CFP: 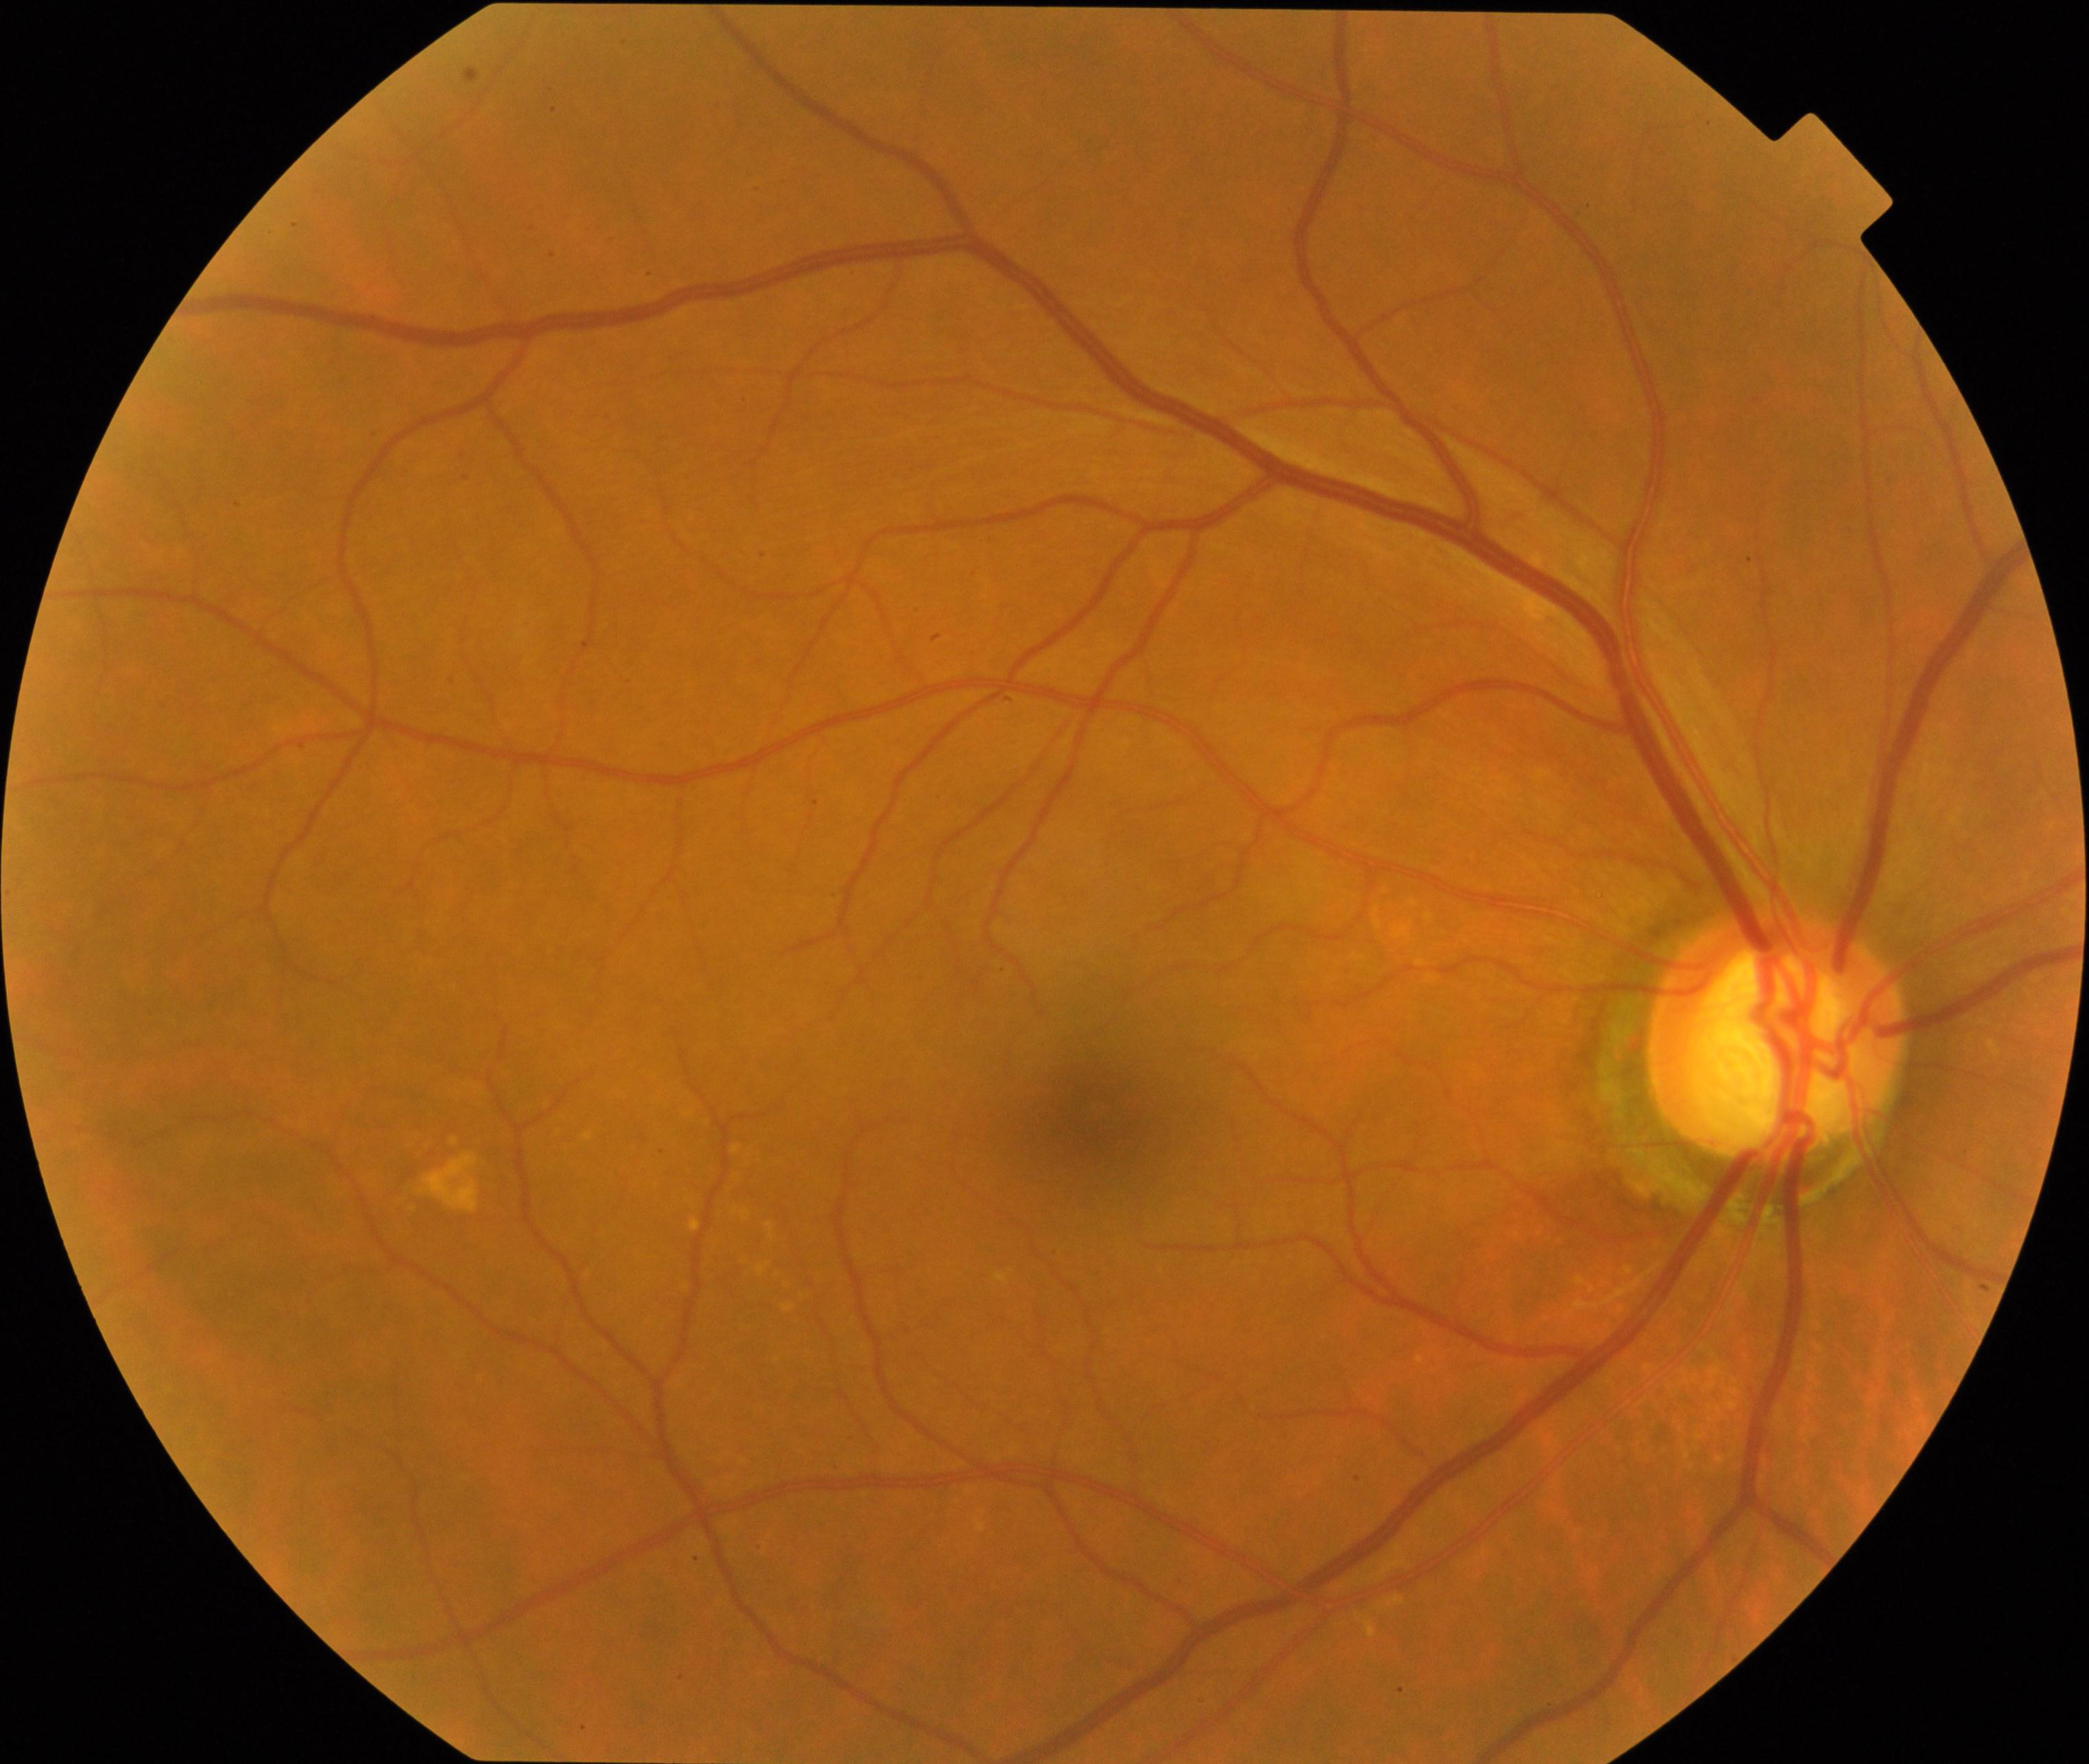
There is evidence of possible glaucoma.